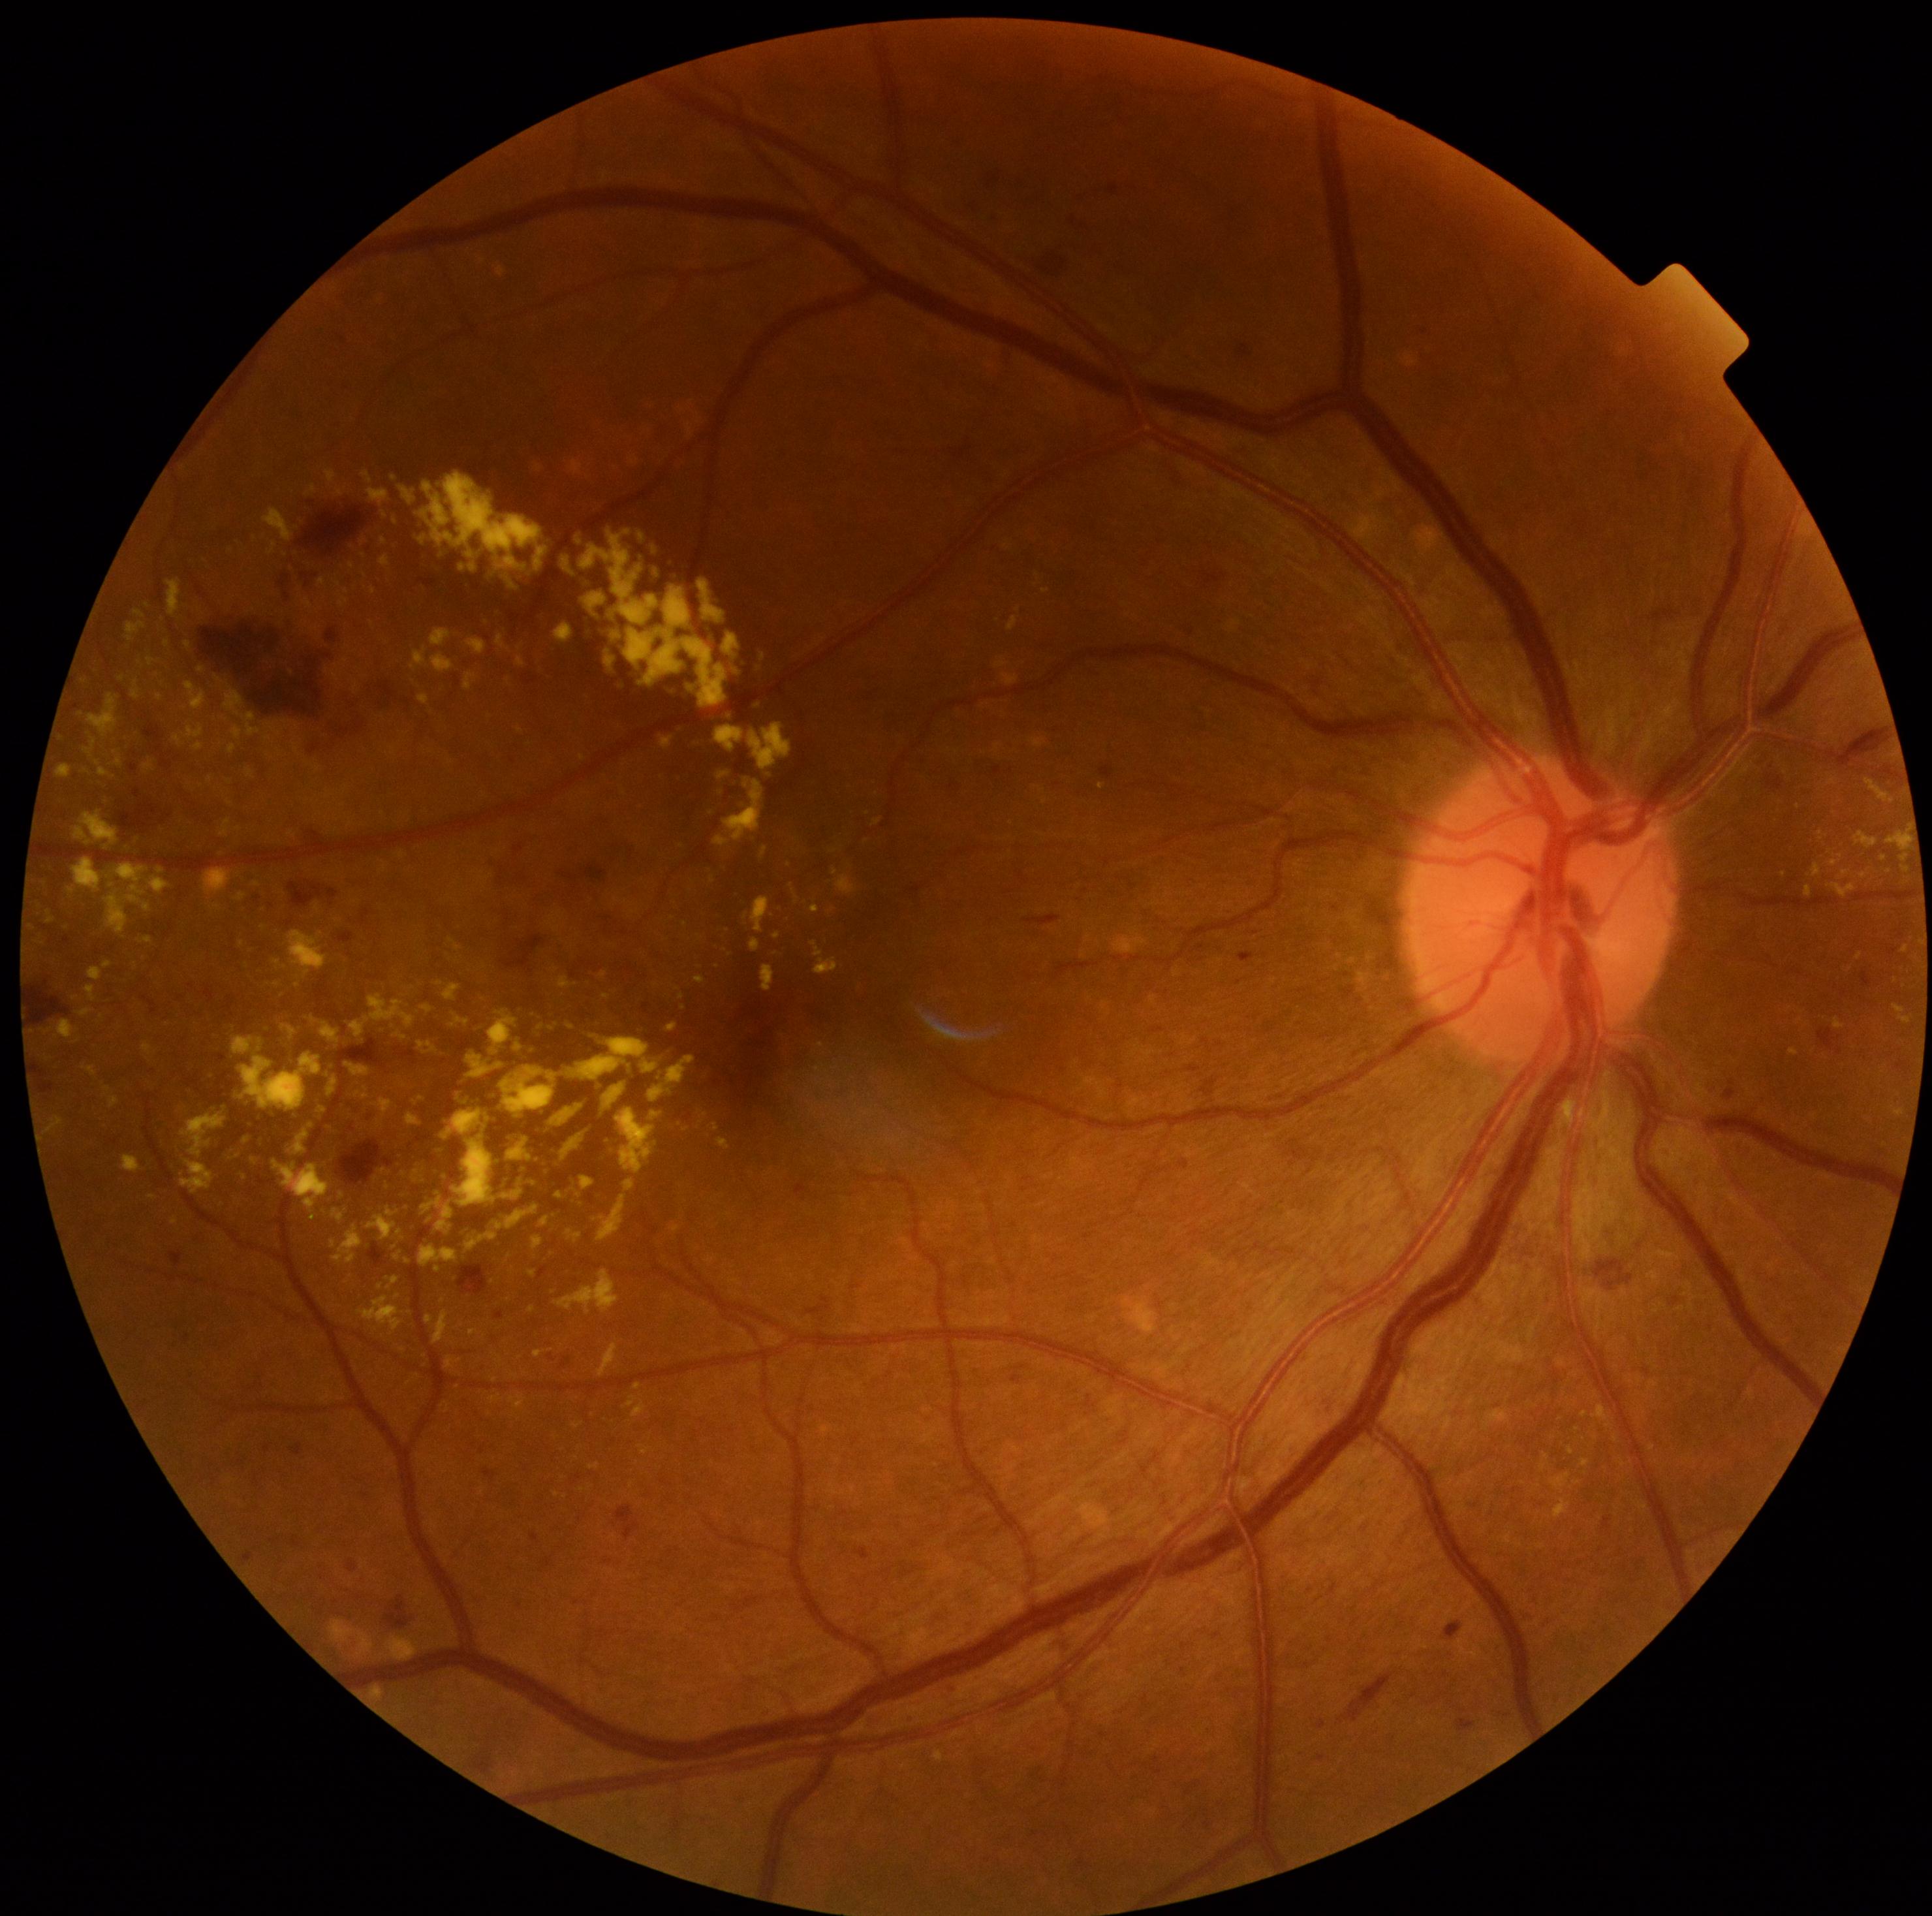
Diabetic retinopathy (DR): 2/4
Lesions identified (partial list):
hard exudates (EXs) (more not shown): Rect(417, 473, 550, 599); Rect(711, 1124, 720, 1131); Rect(630, 456, 639, 466); Rect(421, 1004, 434, 1013); Rect(123, 1155, 143, 1174); Rect(55, 764, 72, 779); Rect(78, 1008, 93, 1017); Rect(411, 646, 455, 675); Rect(700, 1112, 708, 1122); Rect(446, 1357, 460, 1370); Rect(220, 715, 230, 723); Rect(751, 898, 770, 934); Rect(707, 1256, 713, 1264)
Smaller EXs around <point>175, 1221</point>; <point>689, 438</point>; <point>257, 884</point>; <point>791, 1276</point>; <point>86, 770</point>; <point>606, 997</point>; <point>1884, 857</point>
microaneurysms (MAs) (more not shown): Rect(335, 333, 348, 345); Rect(561, 1357, 570, 1370); Rect(369, 1243, 386, 1268); Rect(360, 907, 373, 926); Rect(204, 986, 215, 1003); Rect(482, 1469, 498, 1482); Rect(809, 1407, 817, 1413); Rect(1238, 952, 1255, 964); Rect(242, 1552, 254, 1562); Rect(1012, 1375, 1021, 1385); Rect(1263, 1022, 1279, 1037); Rect(1070, 218, 1076, 226); Rect(989, 175, 999, 188); Rect(1318, 1720, 1326, 1730)
Smaller MAs around <point>1062, 1070</point>